2352x1568.
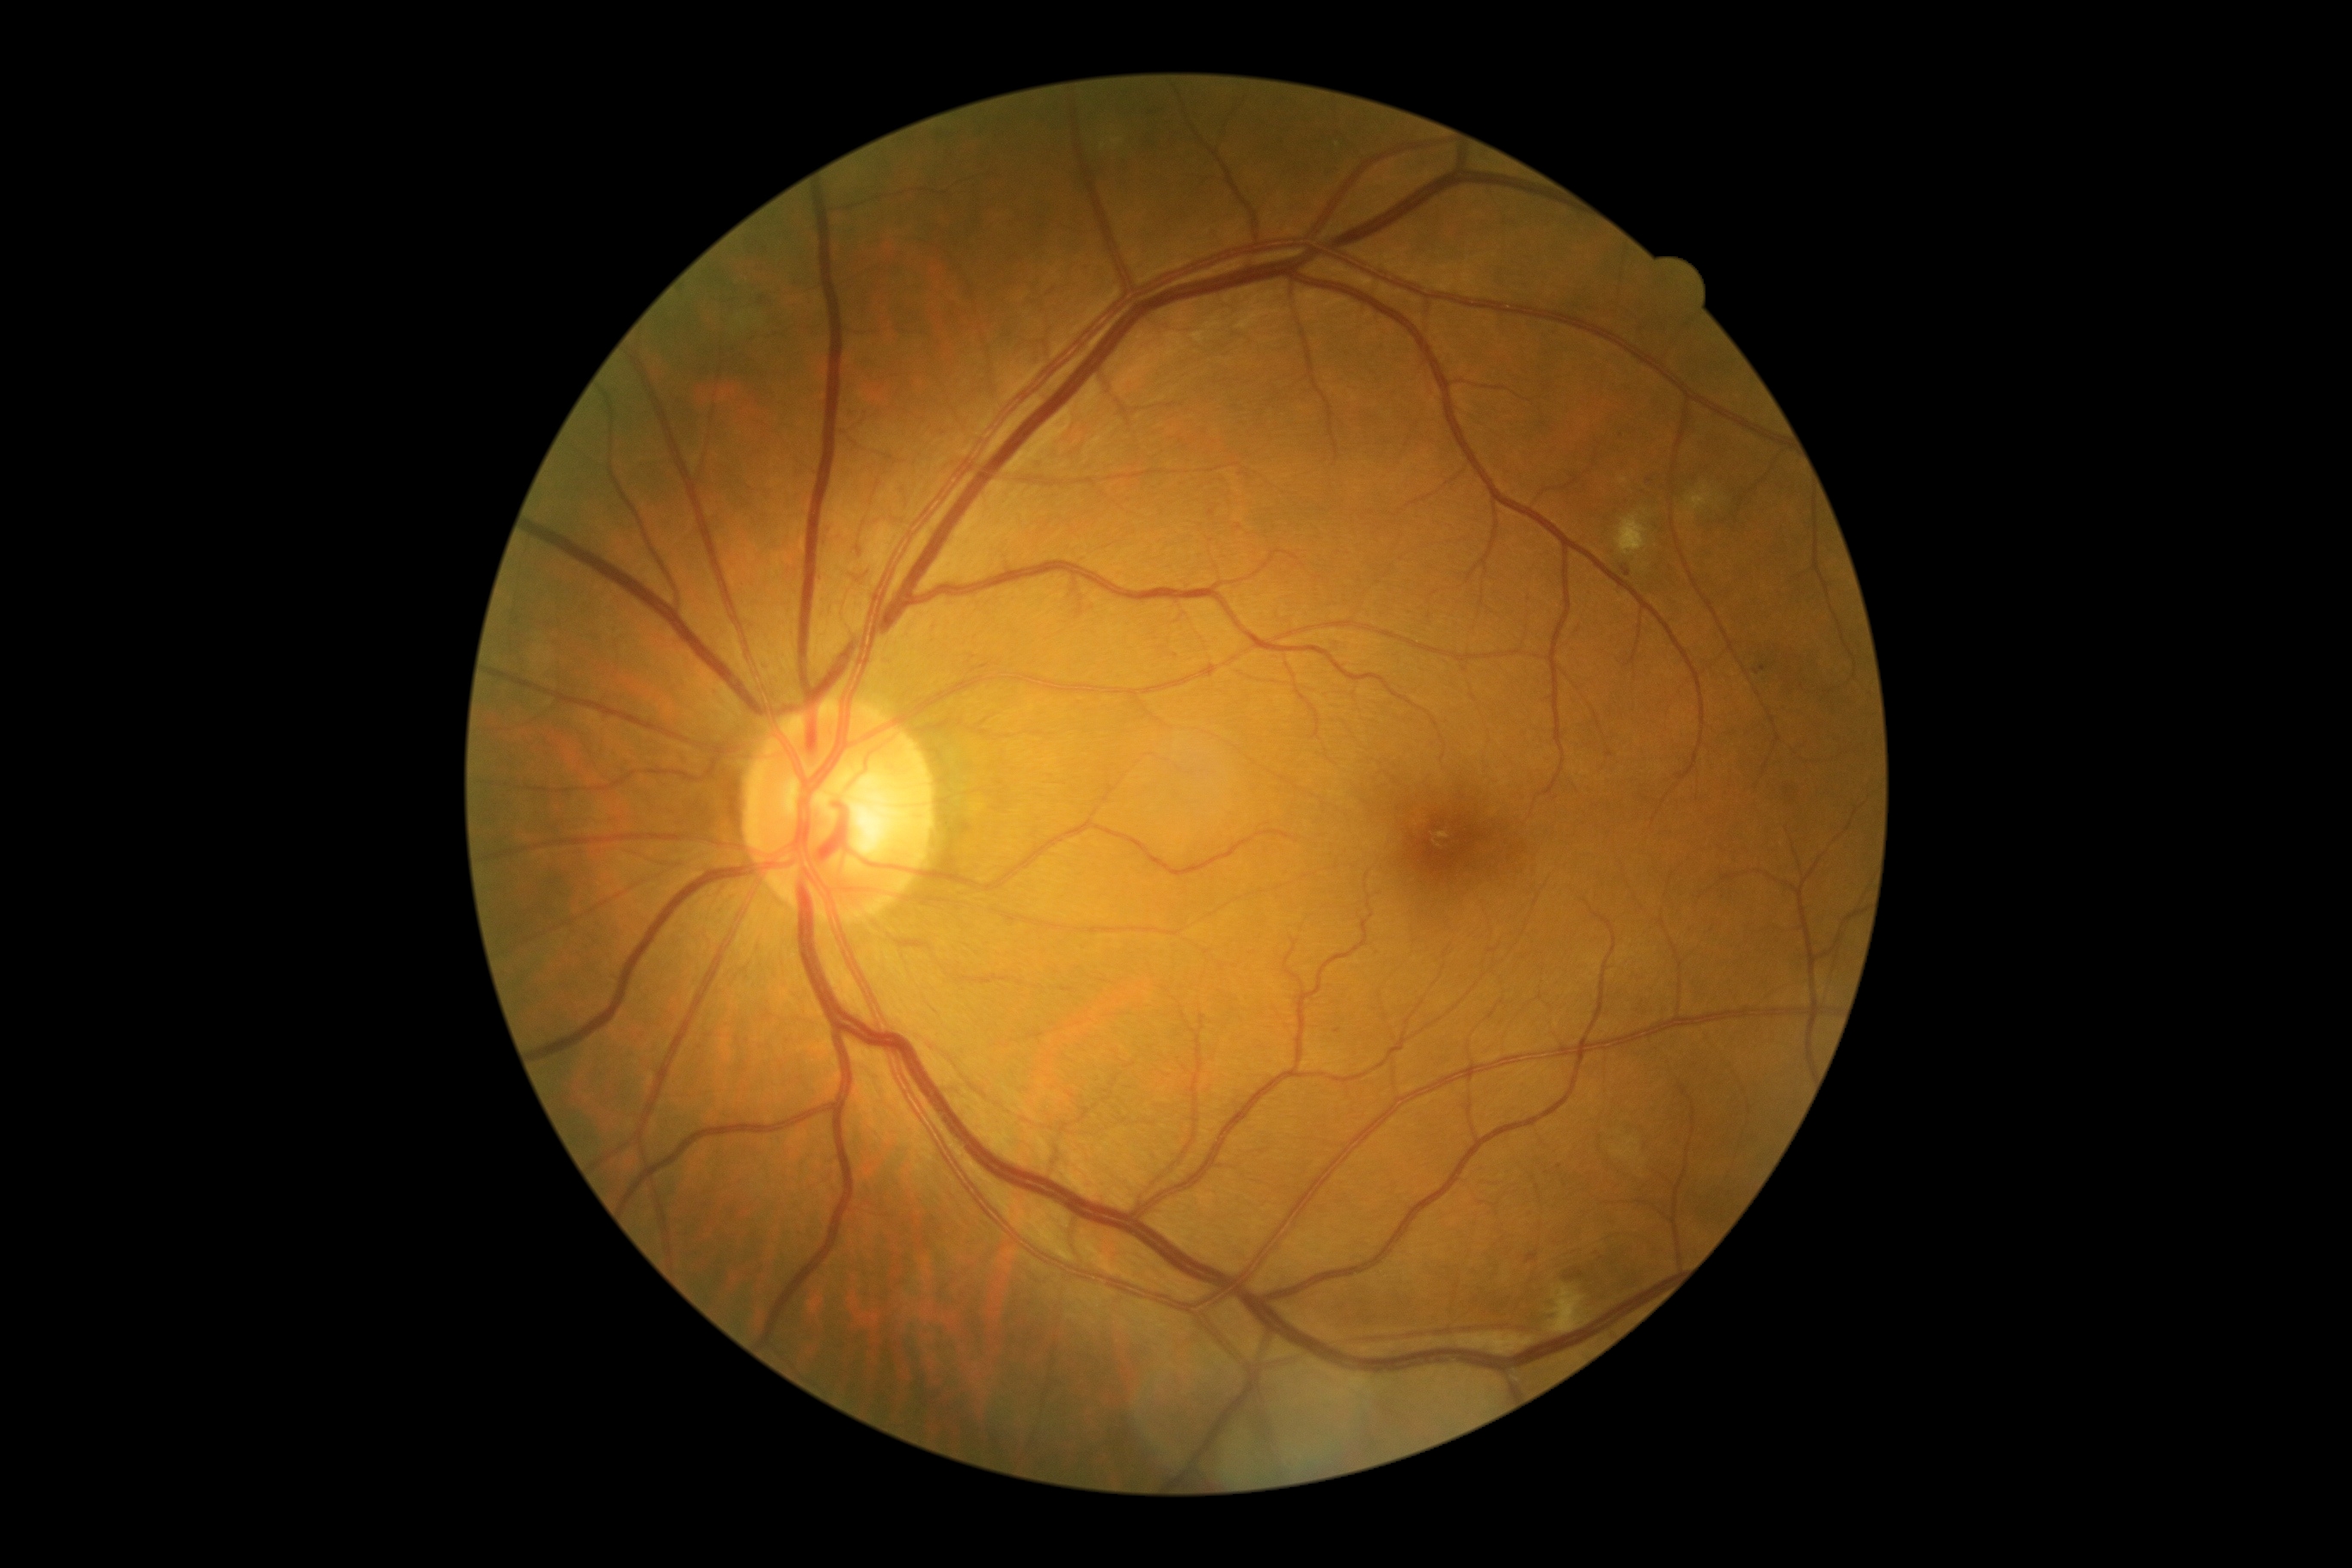

{
  "dr_category": "non-proliferative diabetic retinopathy",
  "dr_grade": "grade 2 (moderate NPDR)"
}